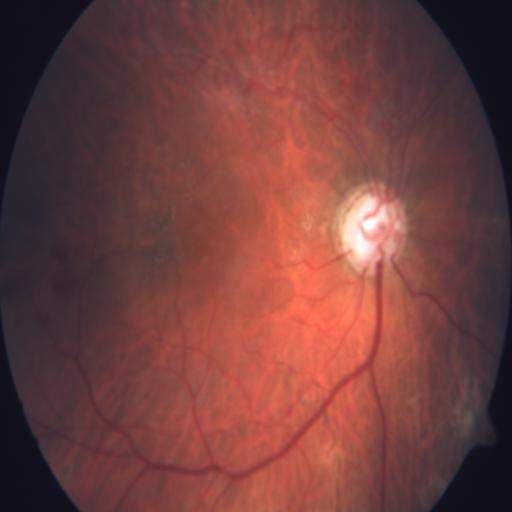
Pathology (2): tortuous vessels (TV), optic disc pallor (ODP).